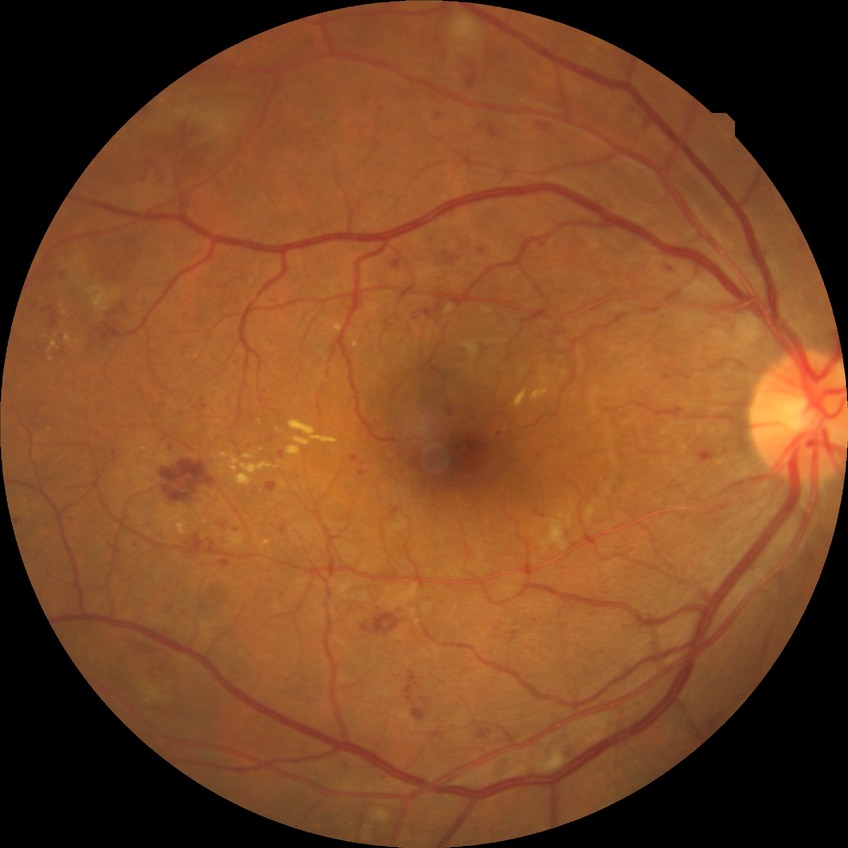 davis_grade: SDR (simple diabetic retinopathy)